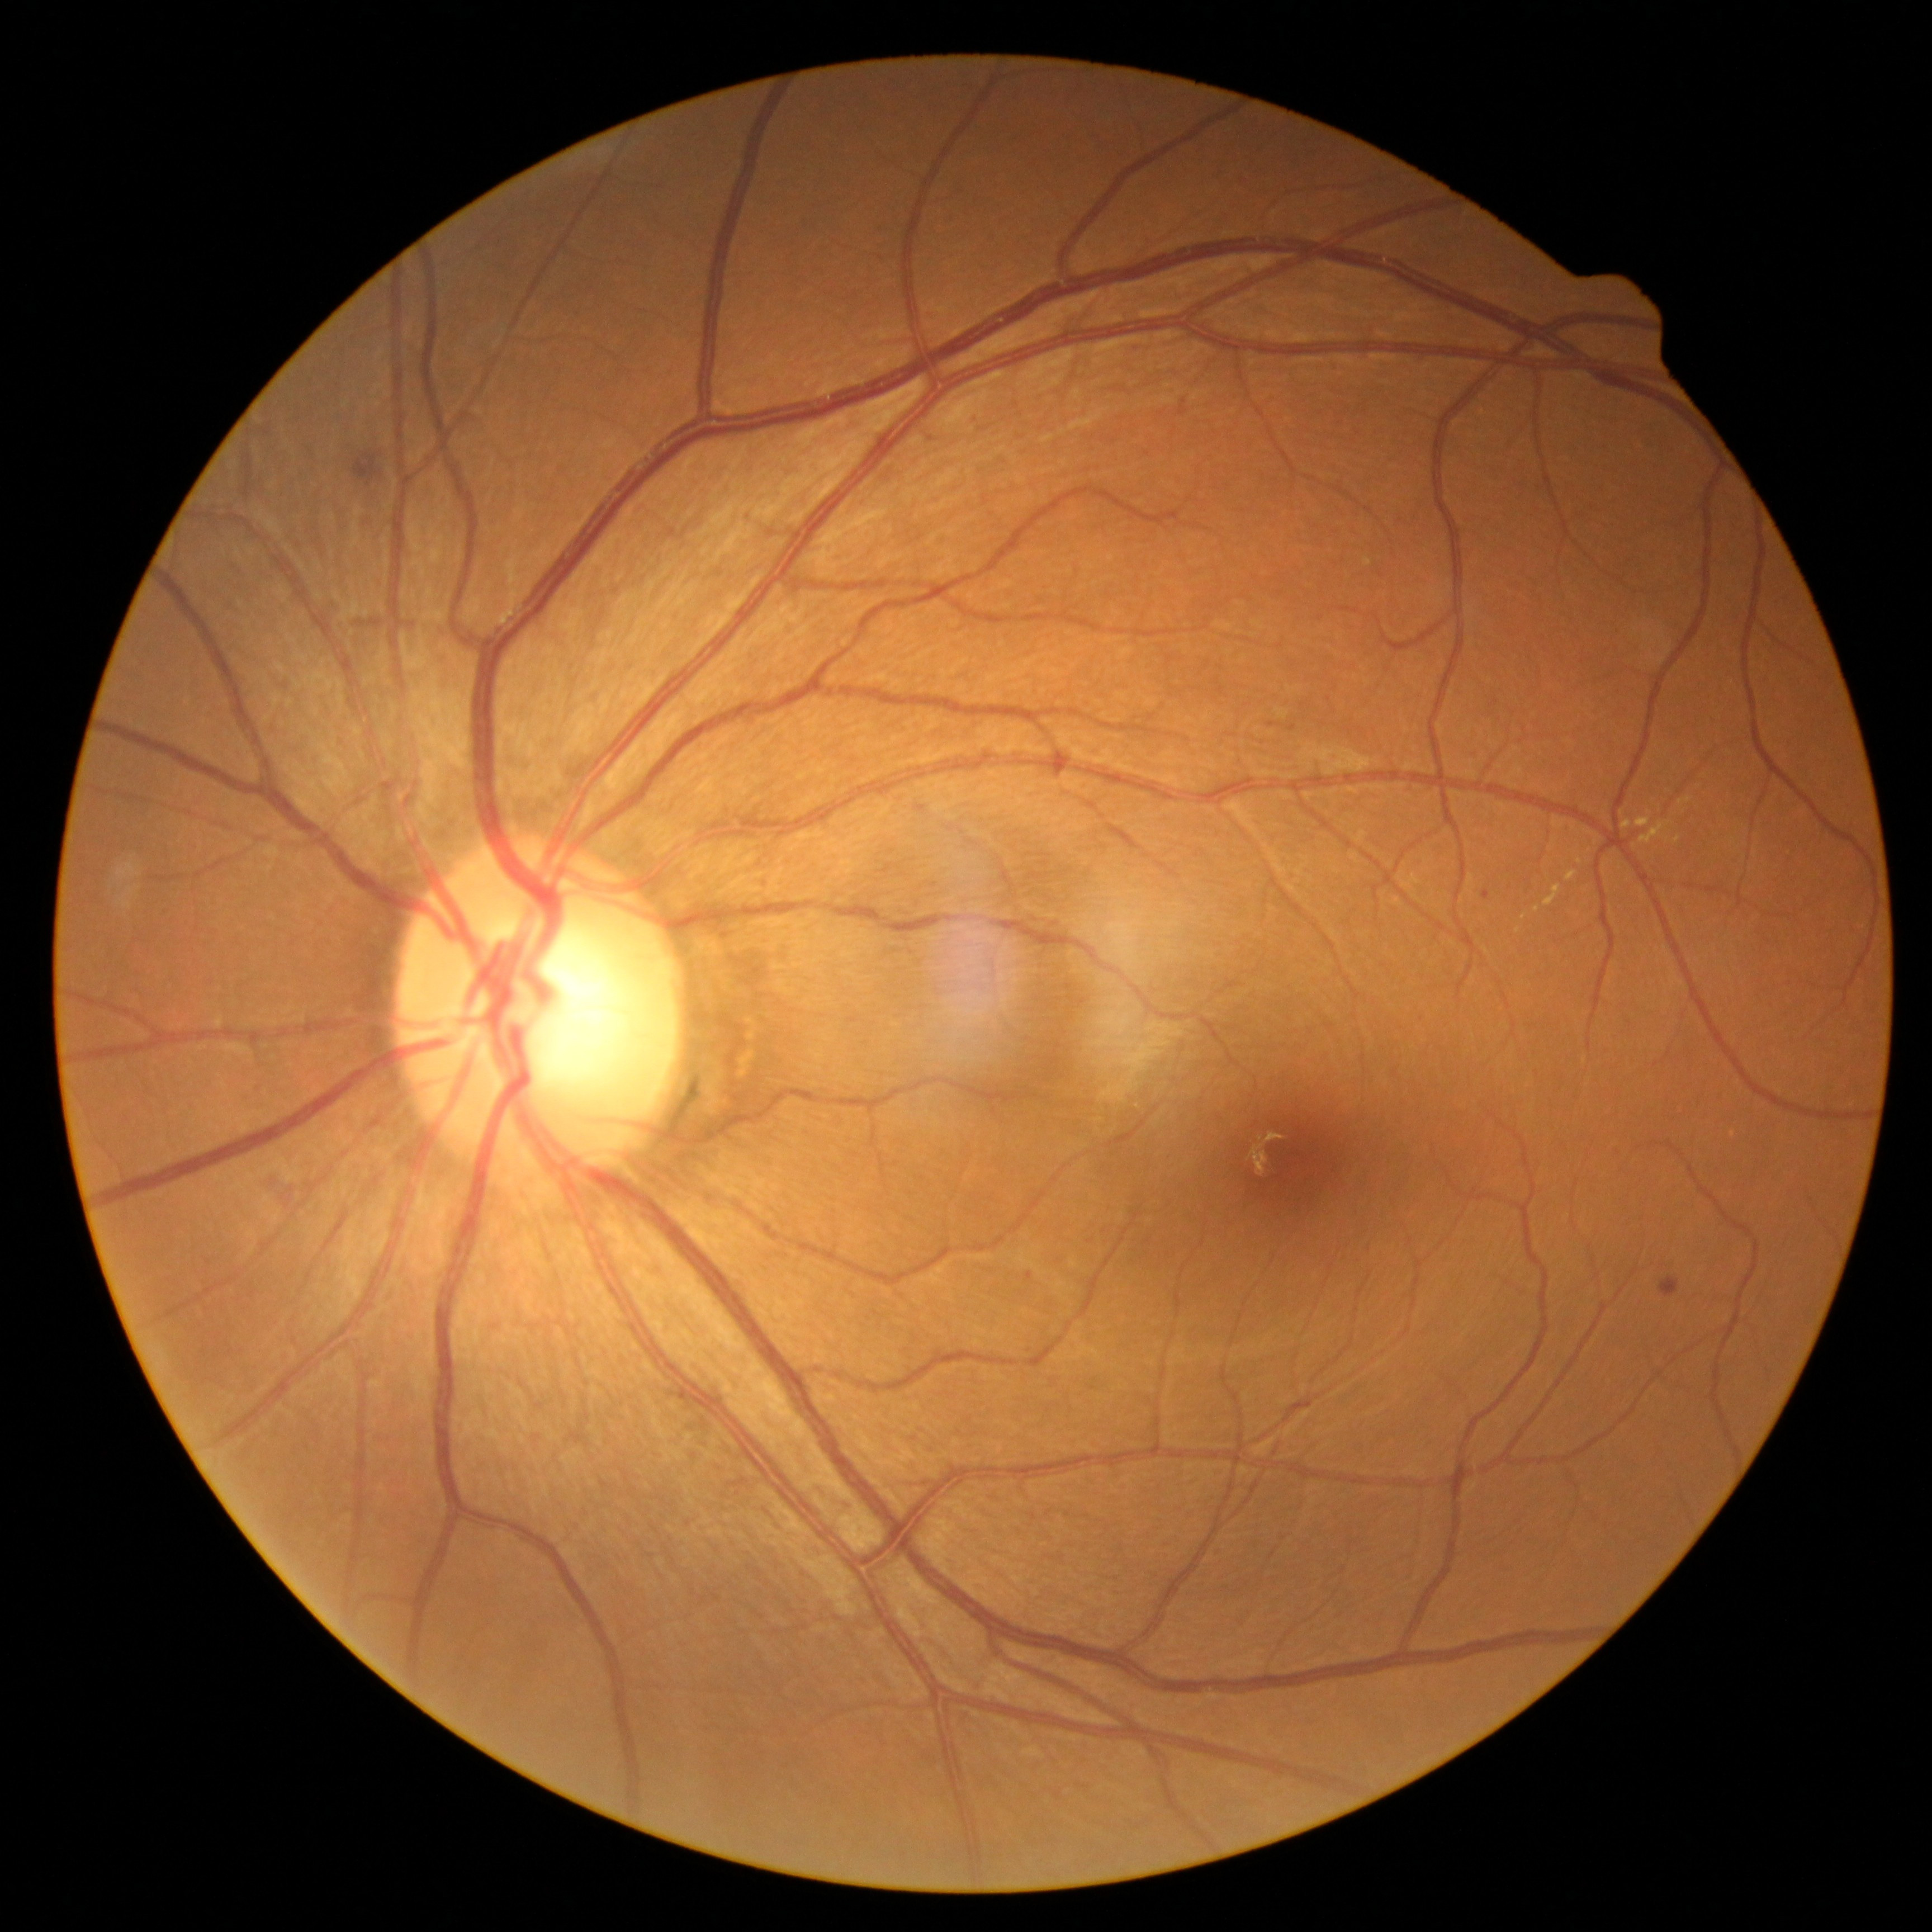
{
  "dr_category": "non-proliferative diabetic retinopathy",
  "dr_grade": "grade 2 (moderate NPDR)"
}